848 x 848 pixels:
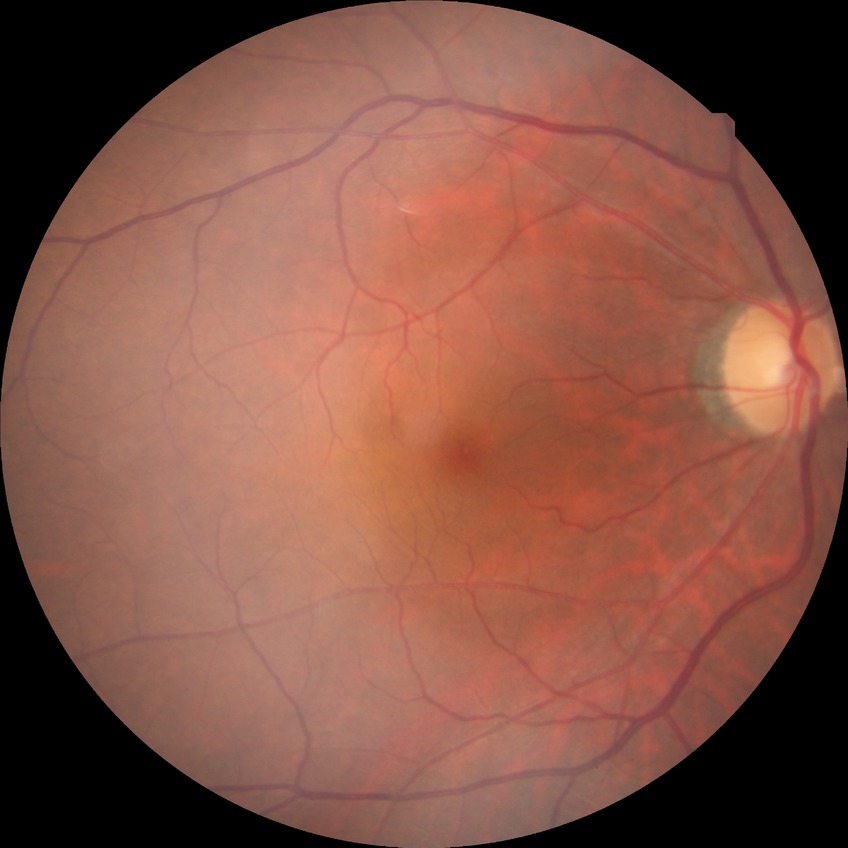 Diabetic retinopathy (DR) is NDR (no diabetic retinopathy).